Color fundus photograph — 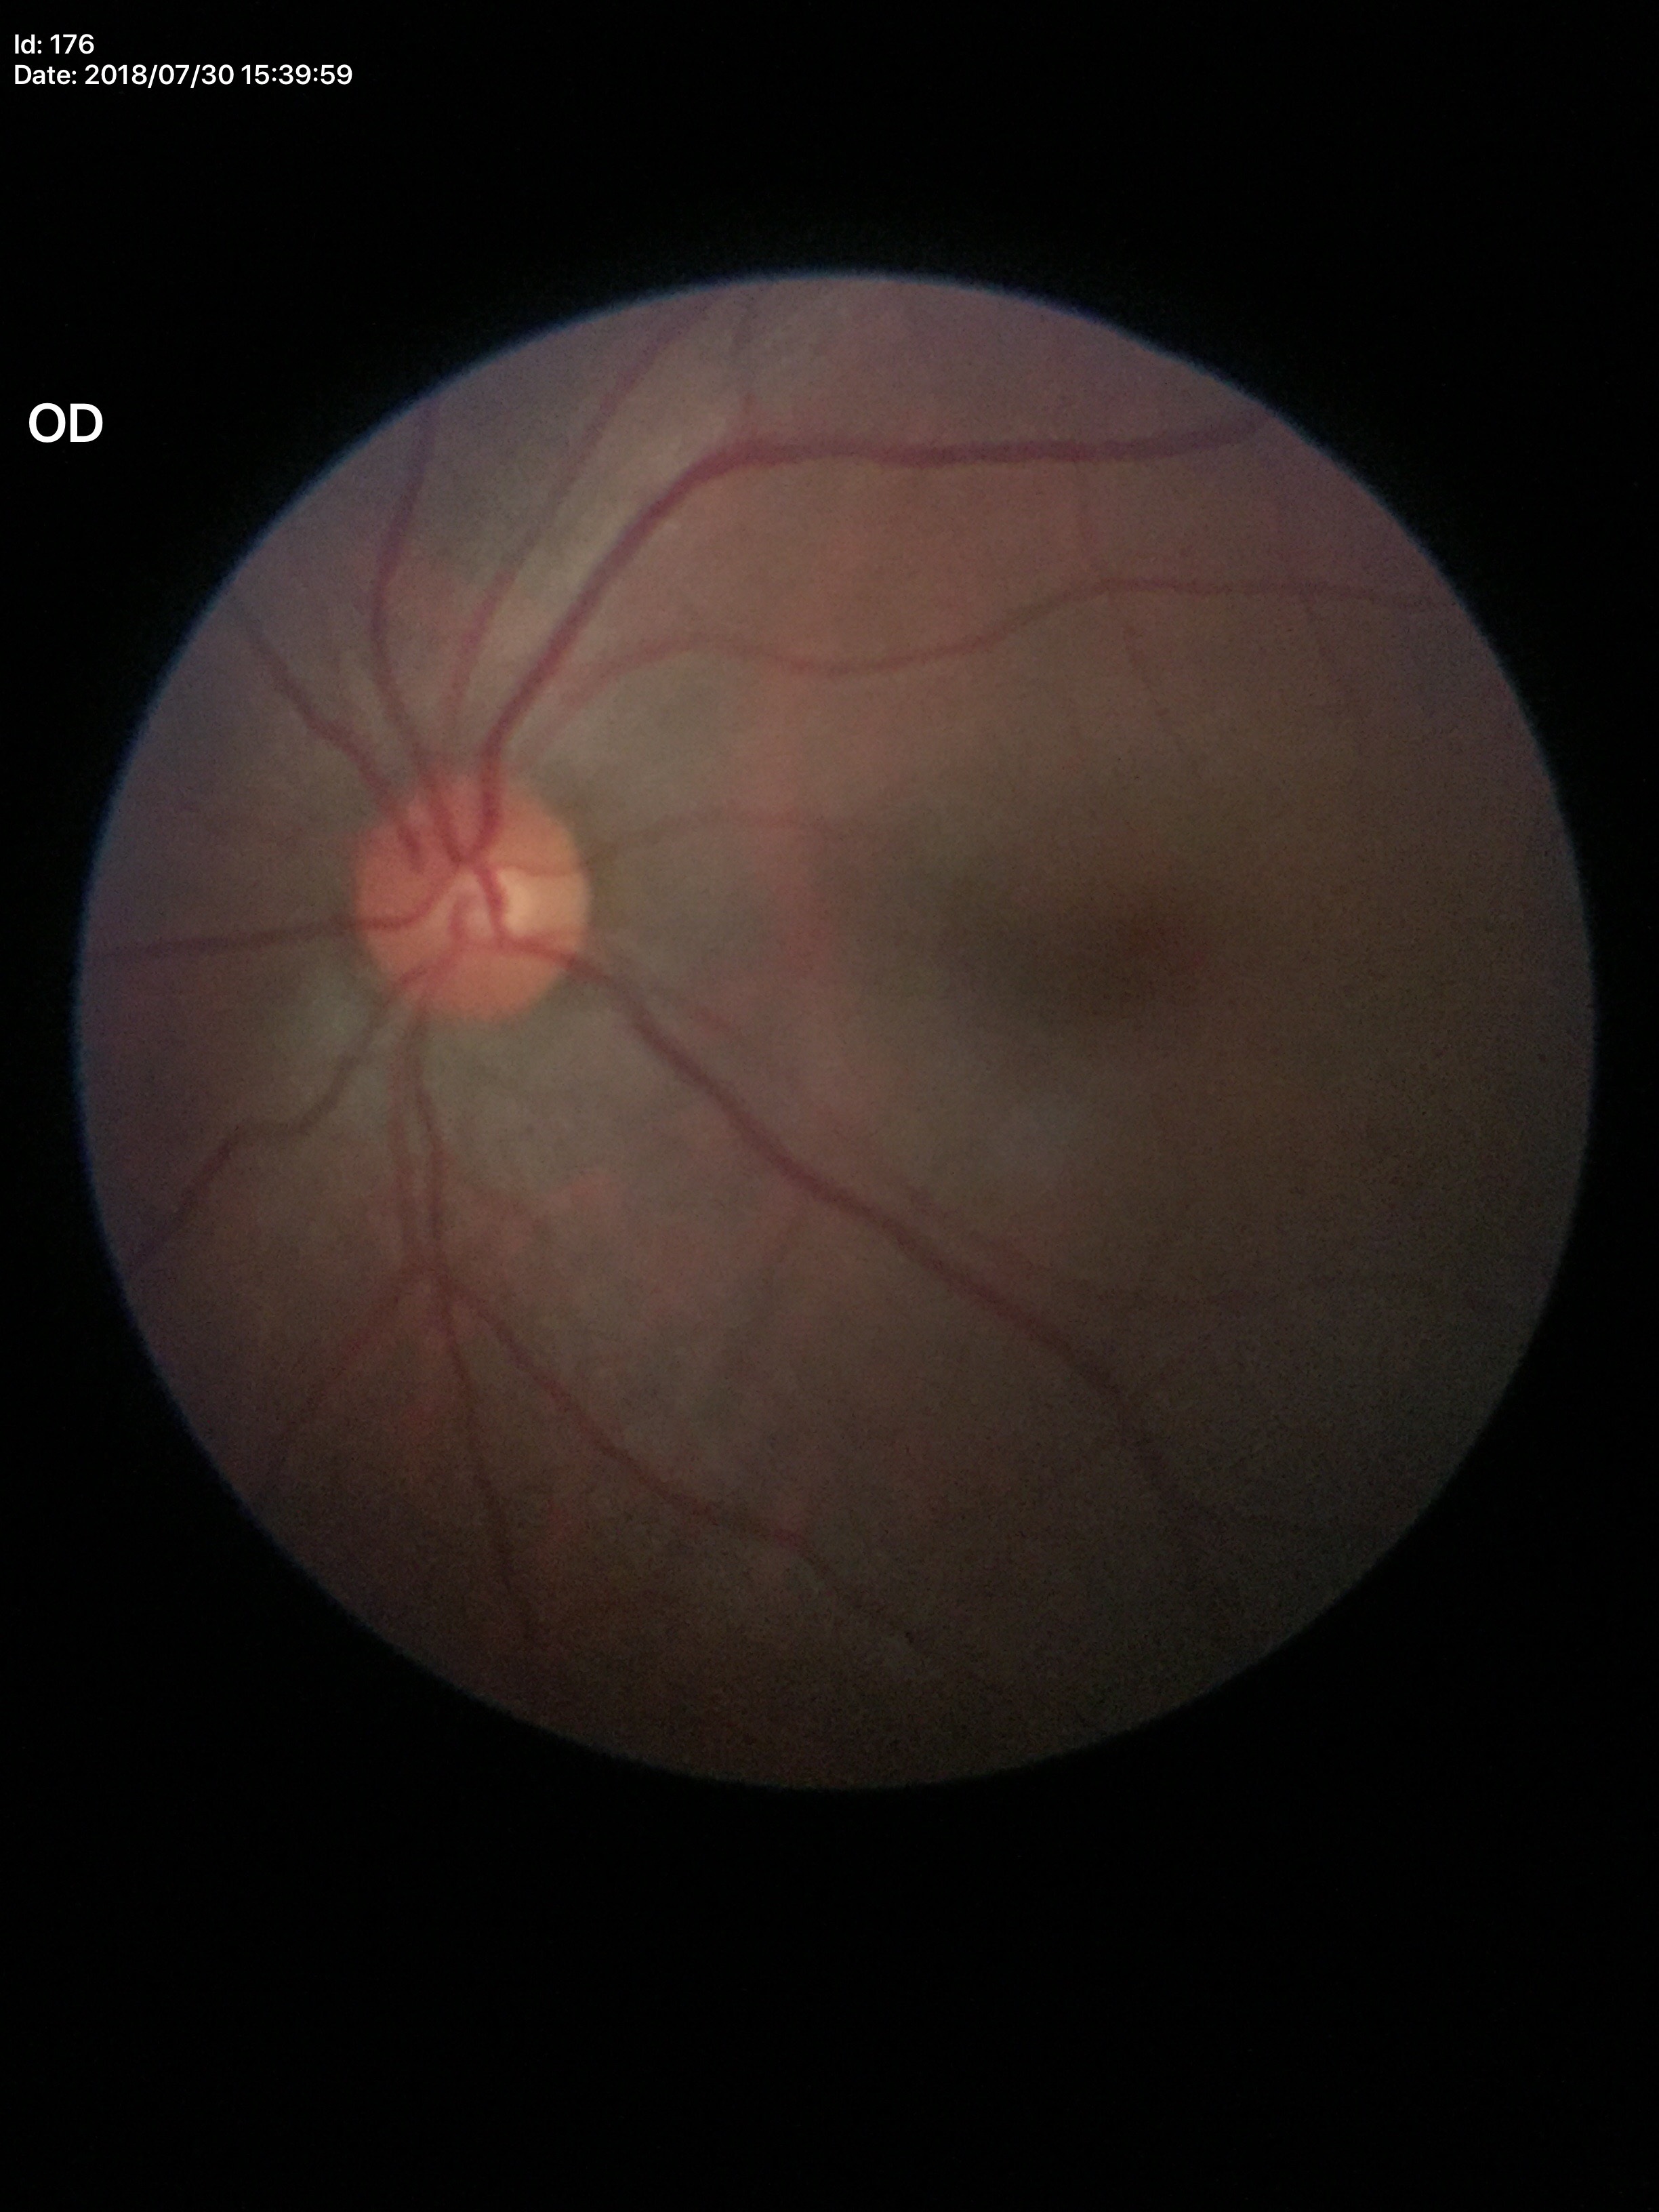
Vertical cup-disc ratio (VCDR) of 0.51.
No signs of glaucoma.